Image size 1240x1240. Wide-field fundus image from infant ROP screening:
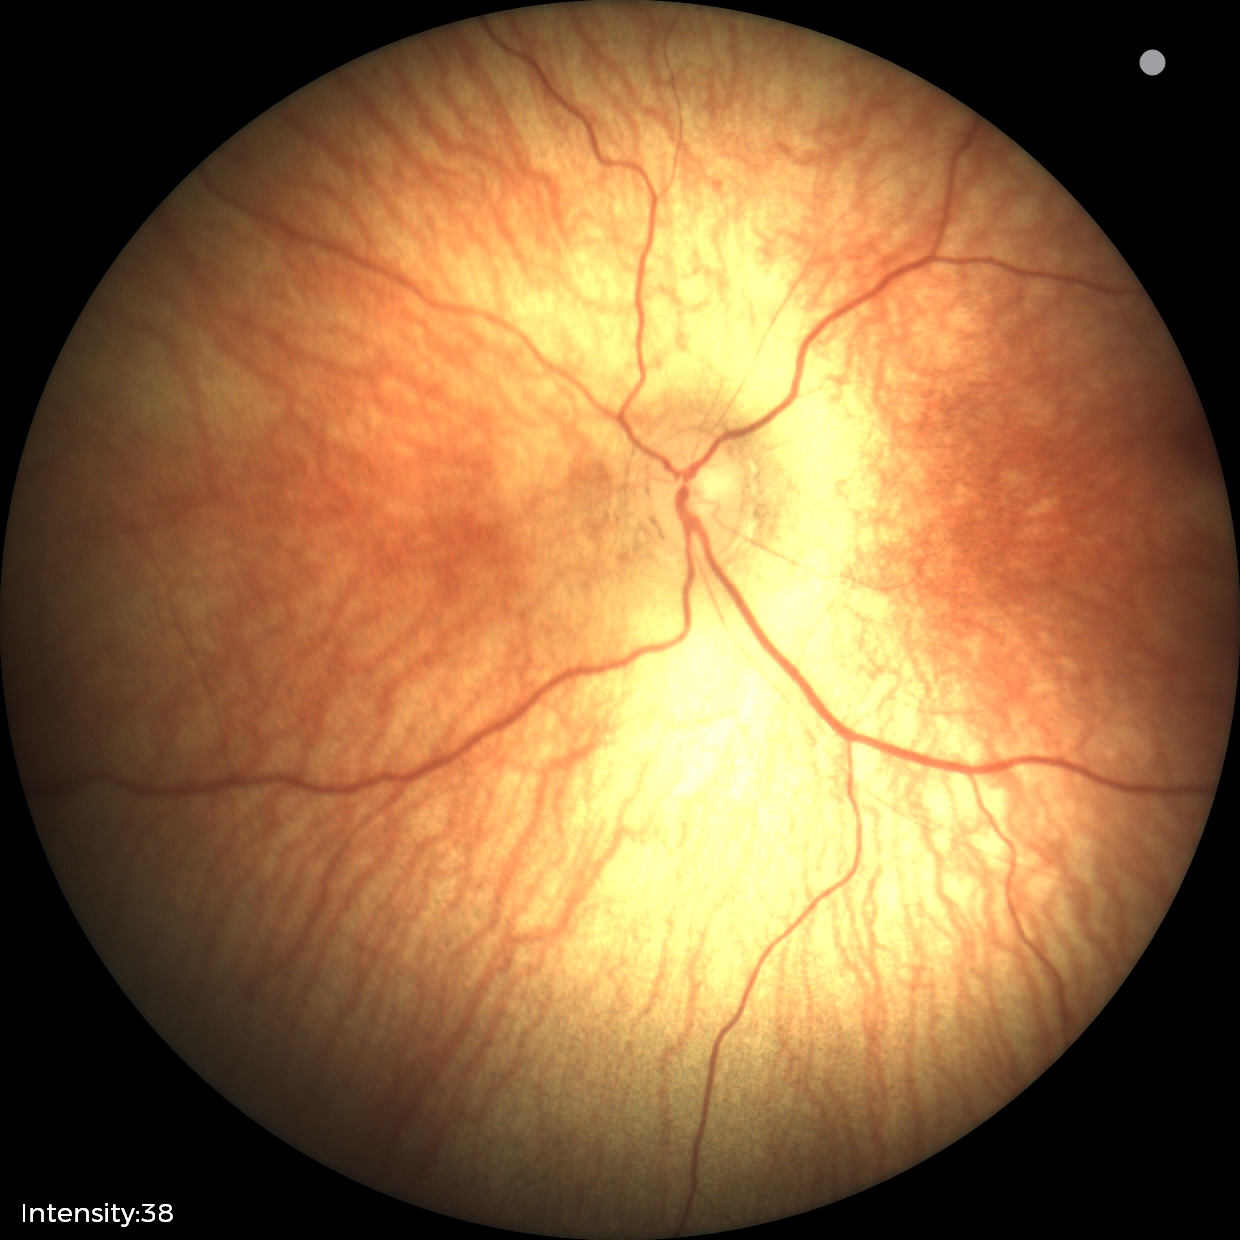 No retinal pathology identified on screening.